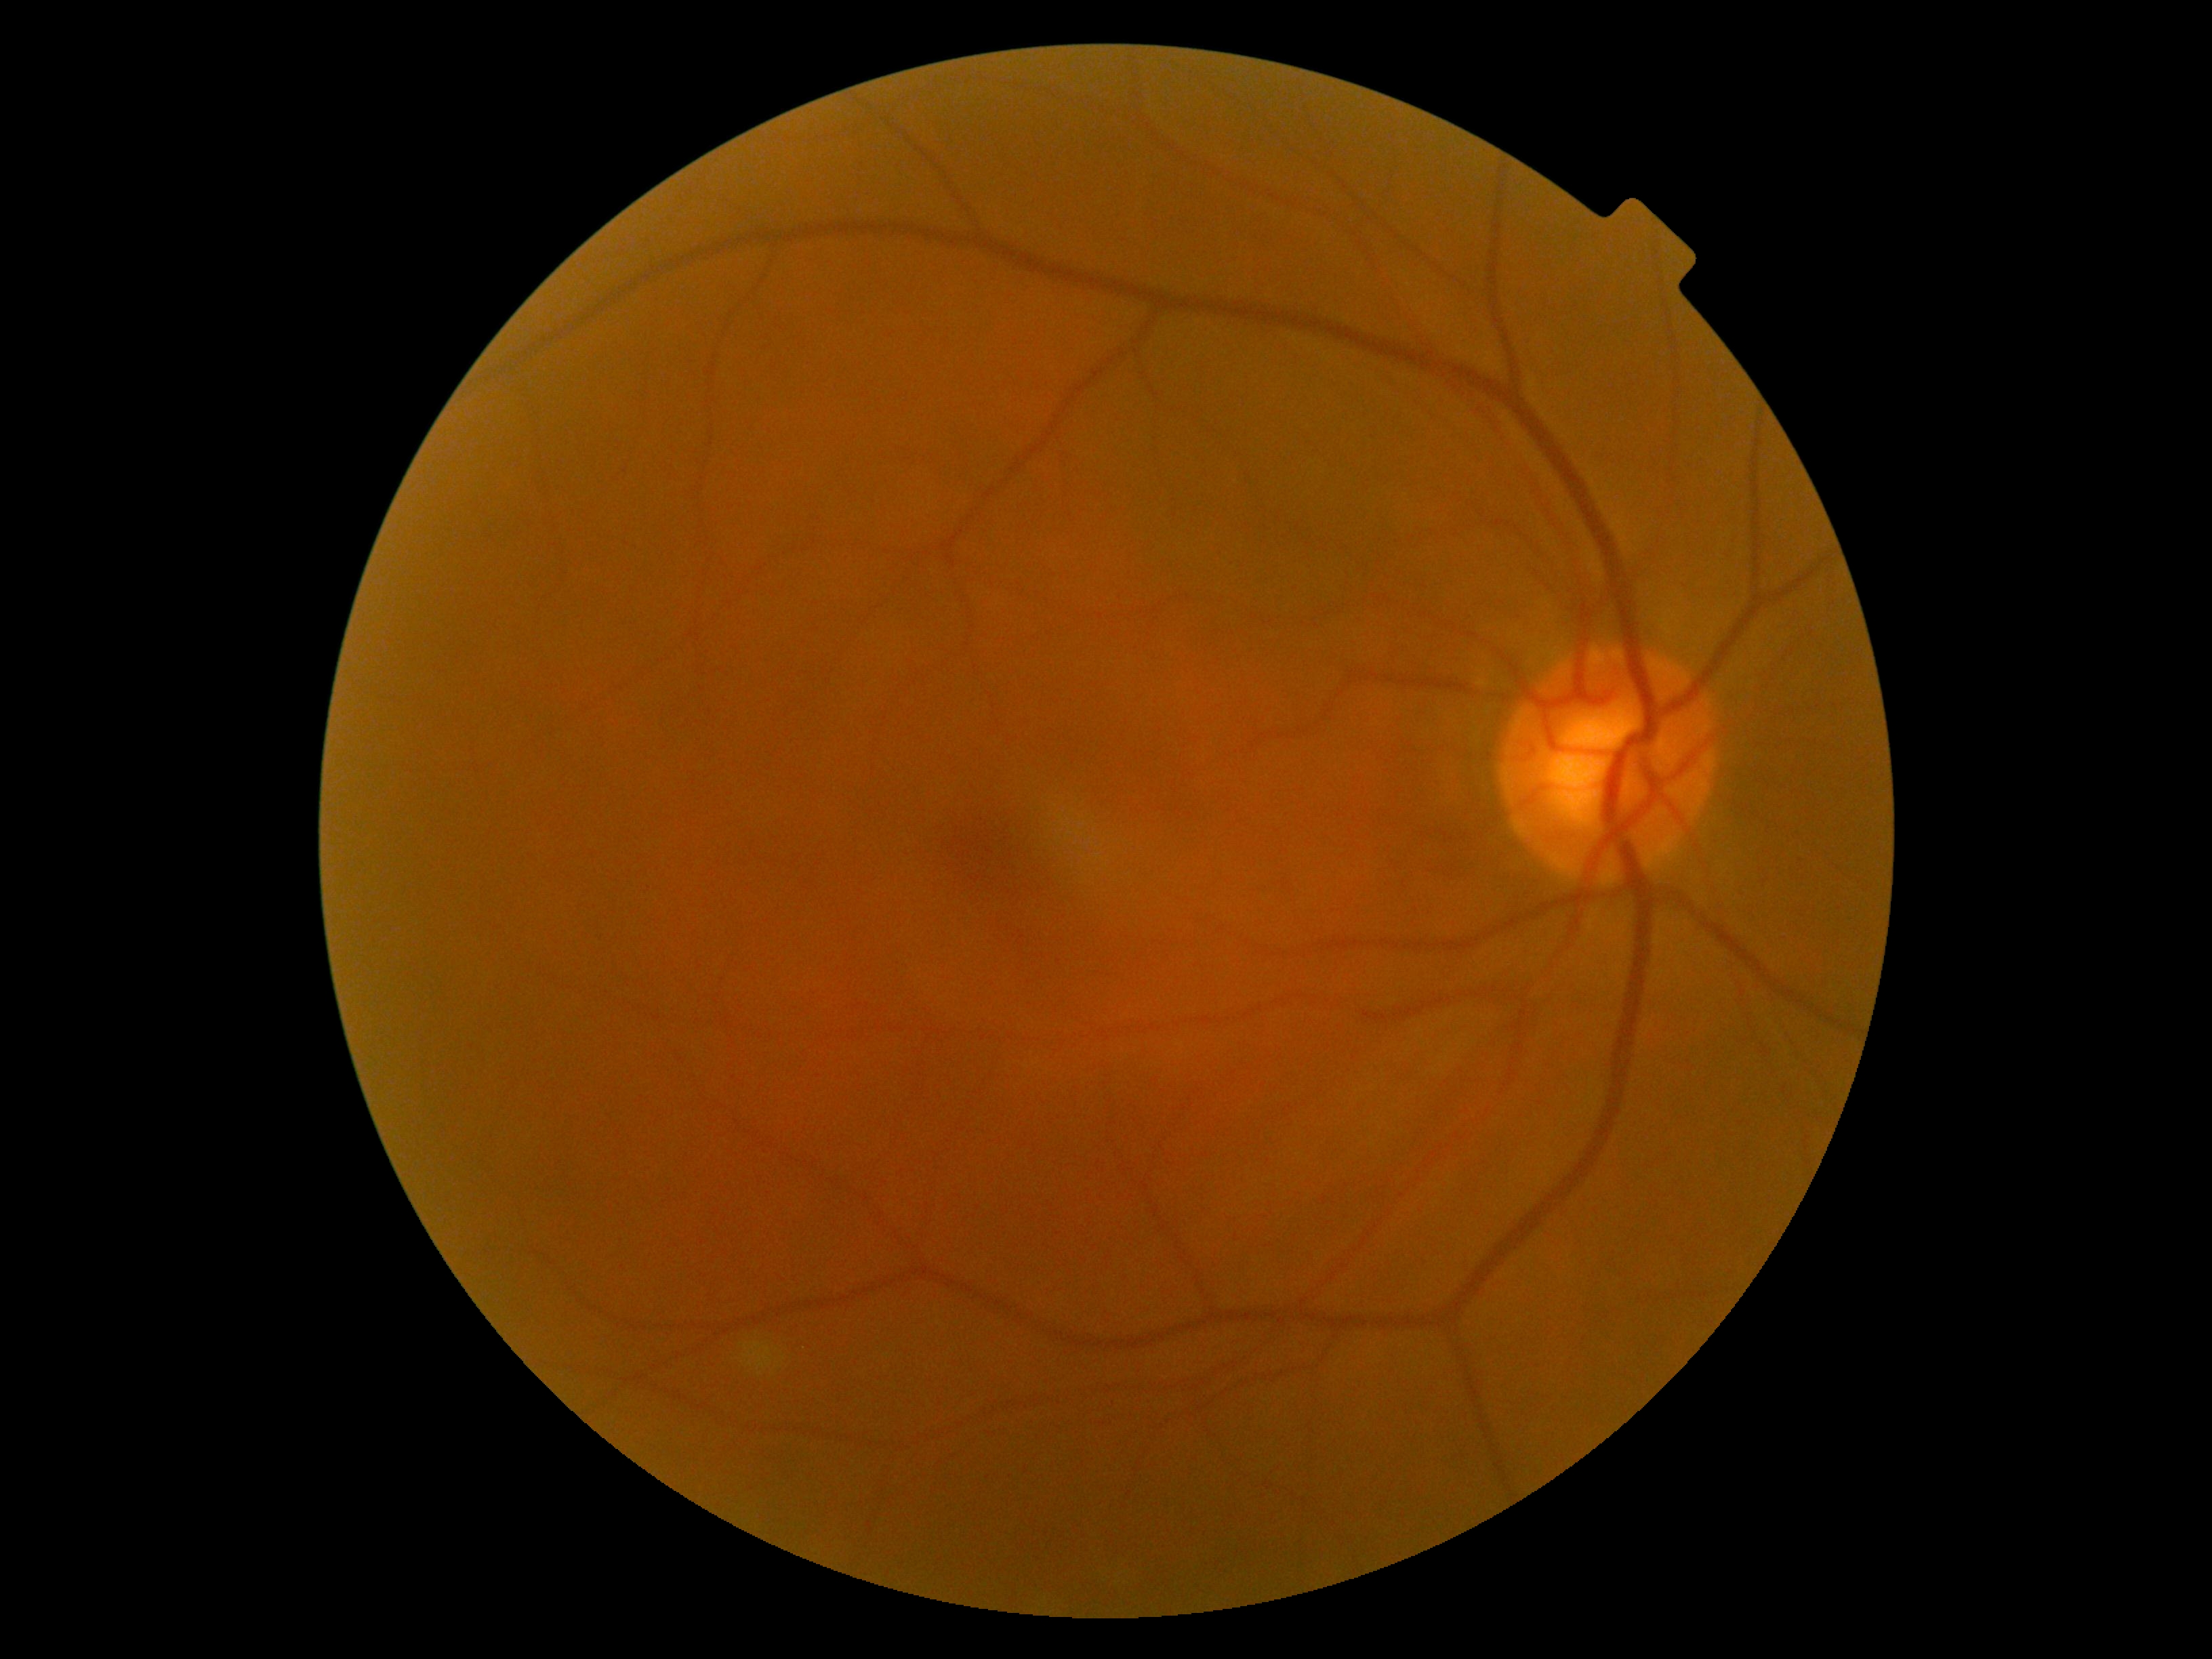 {
  "dr_grade": "grade 0 (no apparent retinopathy)",
  "dr_impression": "negative for DR"
}